Sex: male. Centered on the optic disc. CFP. Image size 2212x1661. Captured without pupil dilation. IOP: 18 mmHg. Central corneal thickness: 599 µm.
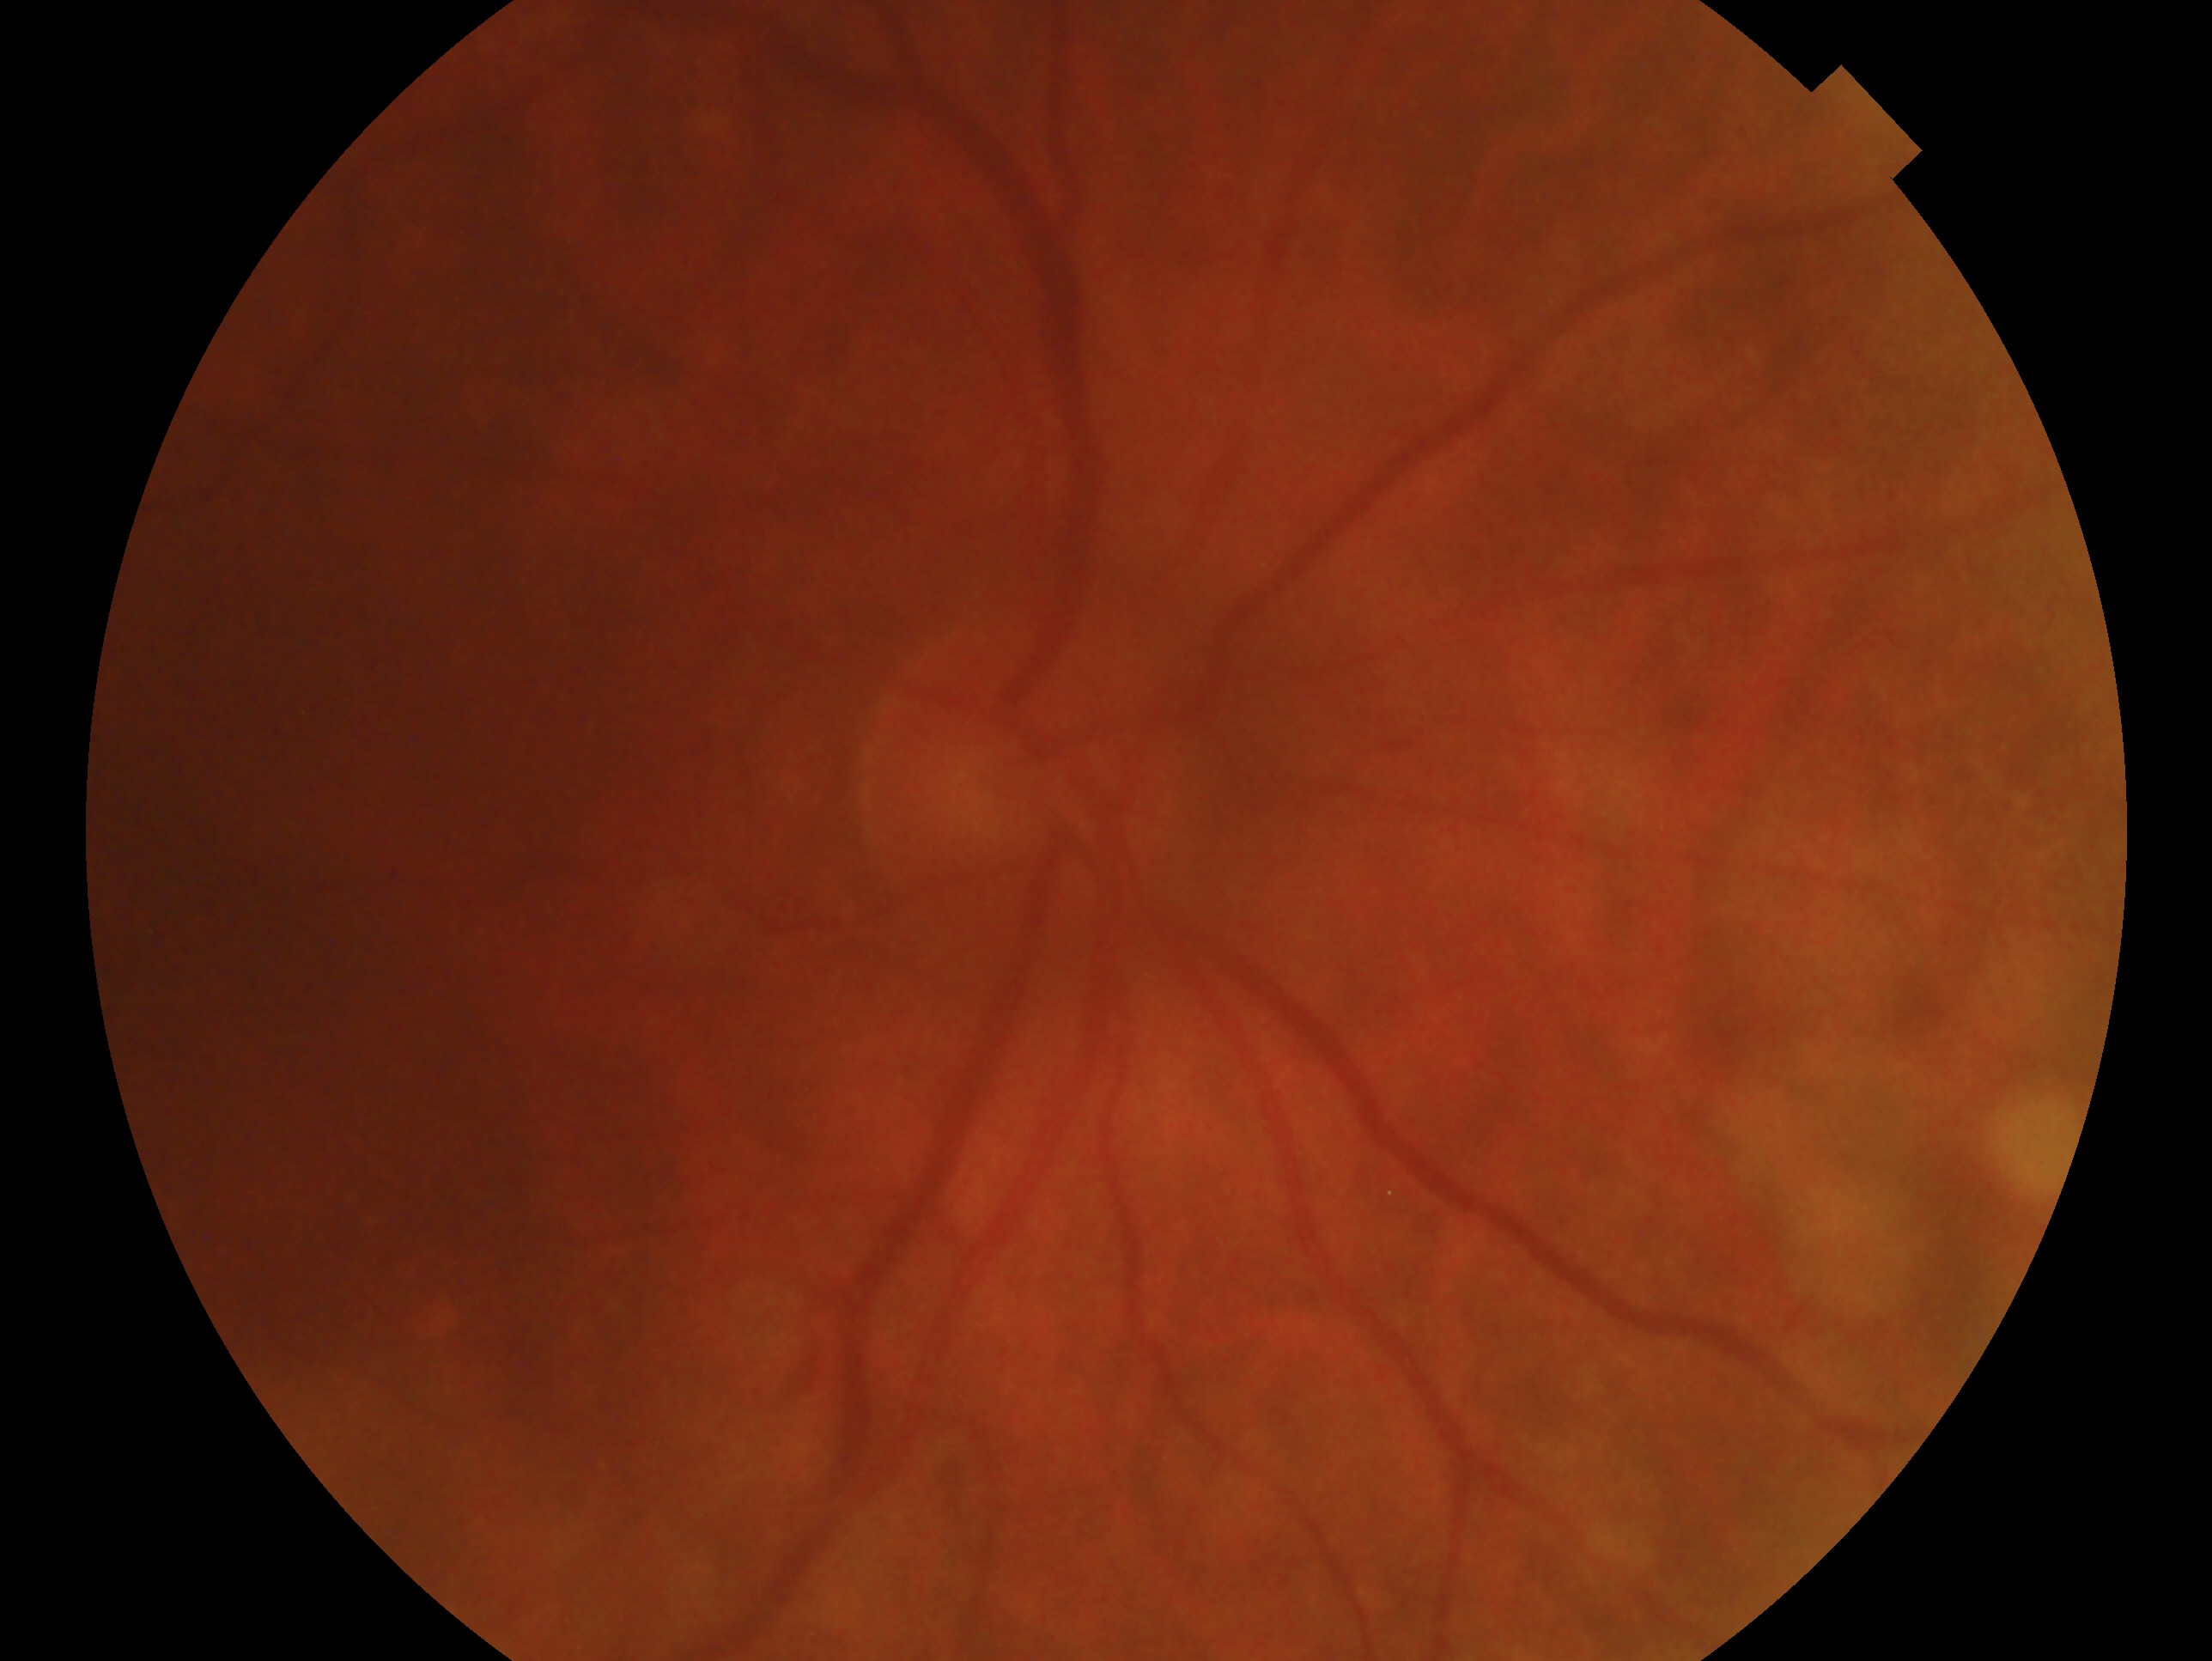 The image shows the right eye. Glaucoma diagnosis: no glaucomatous findings — no clinical evidence of glaucoma in this eye.